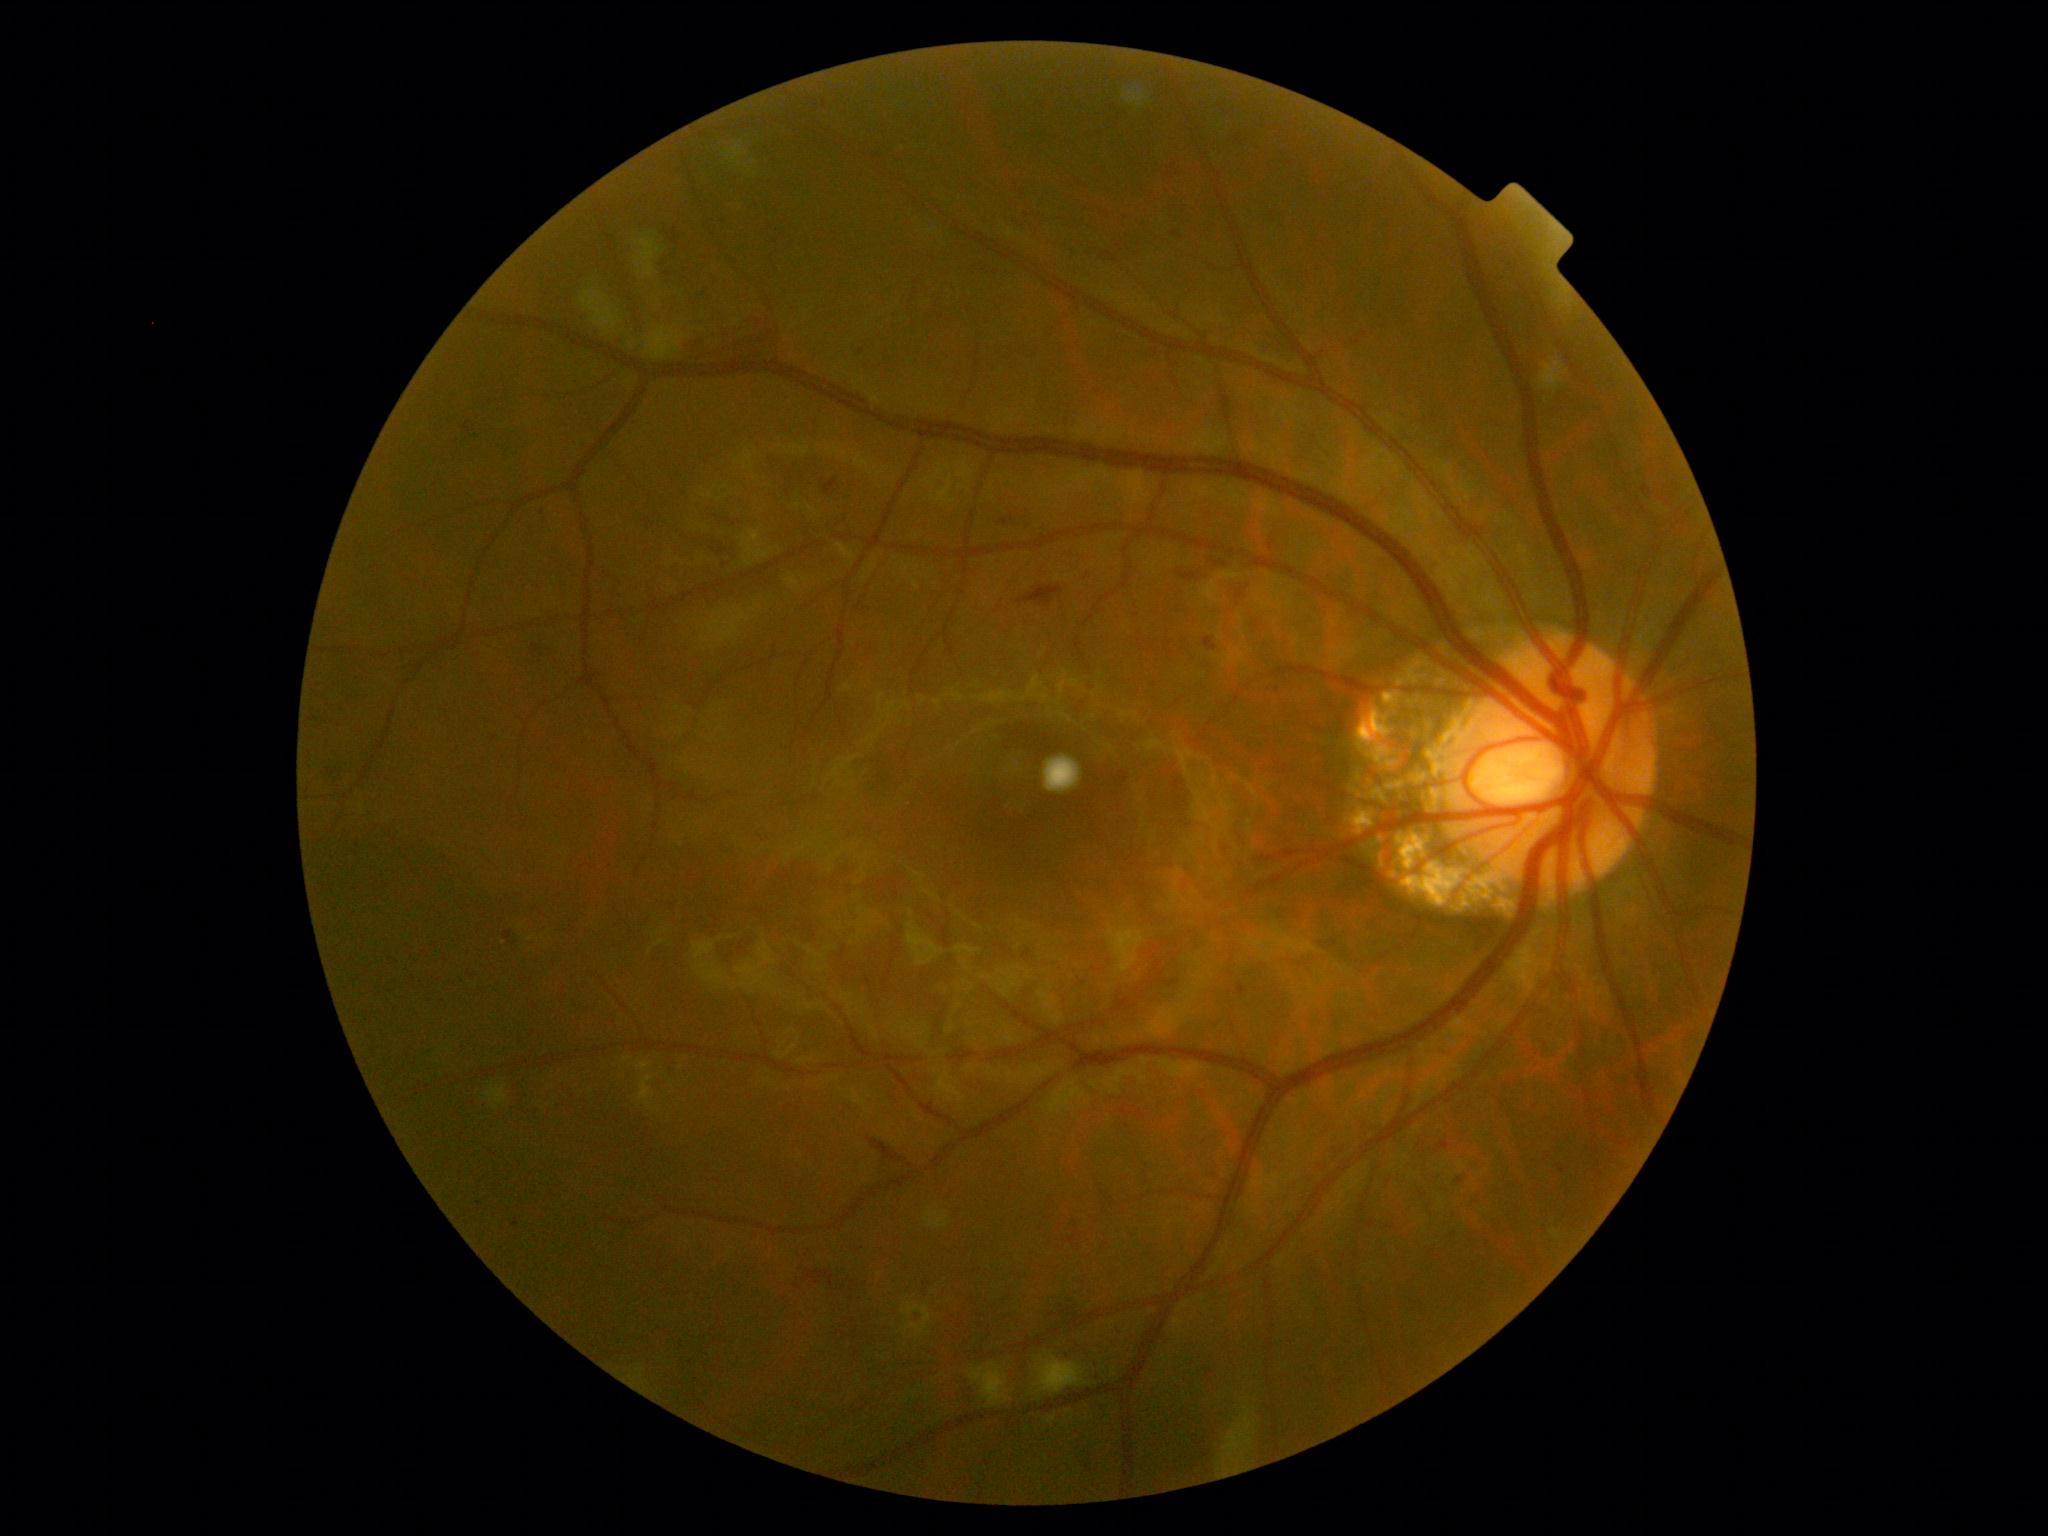

DR grade is 2 (moderate NPDR).